45° field of view, 2352x1568px.
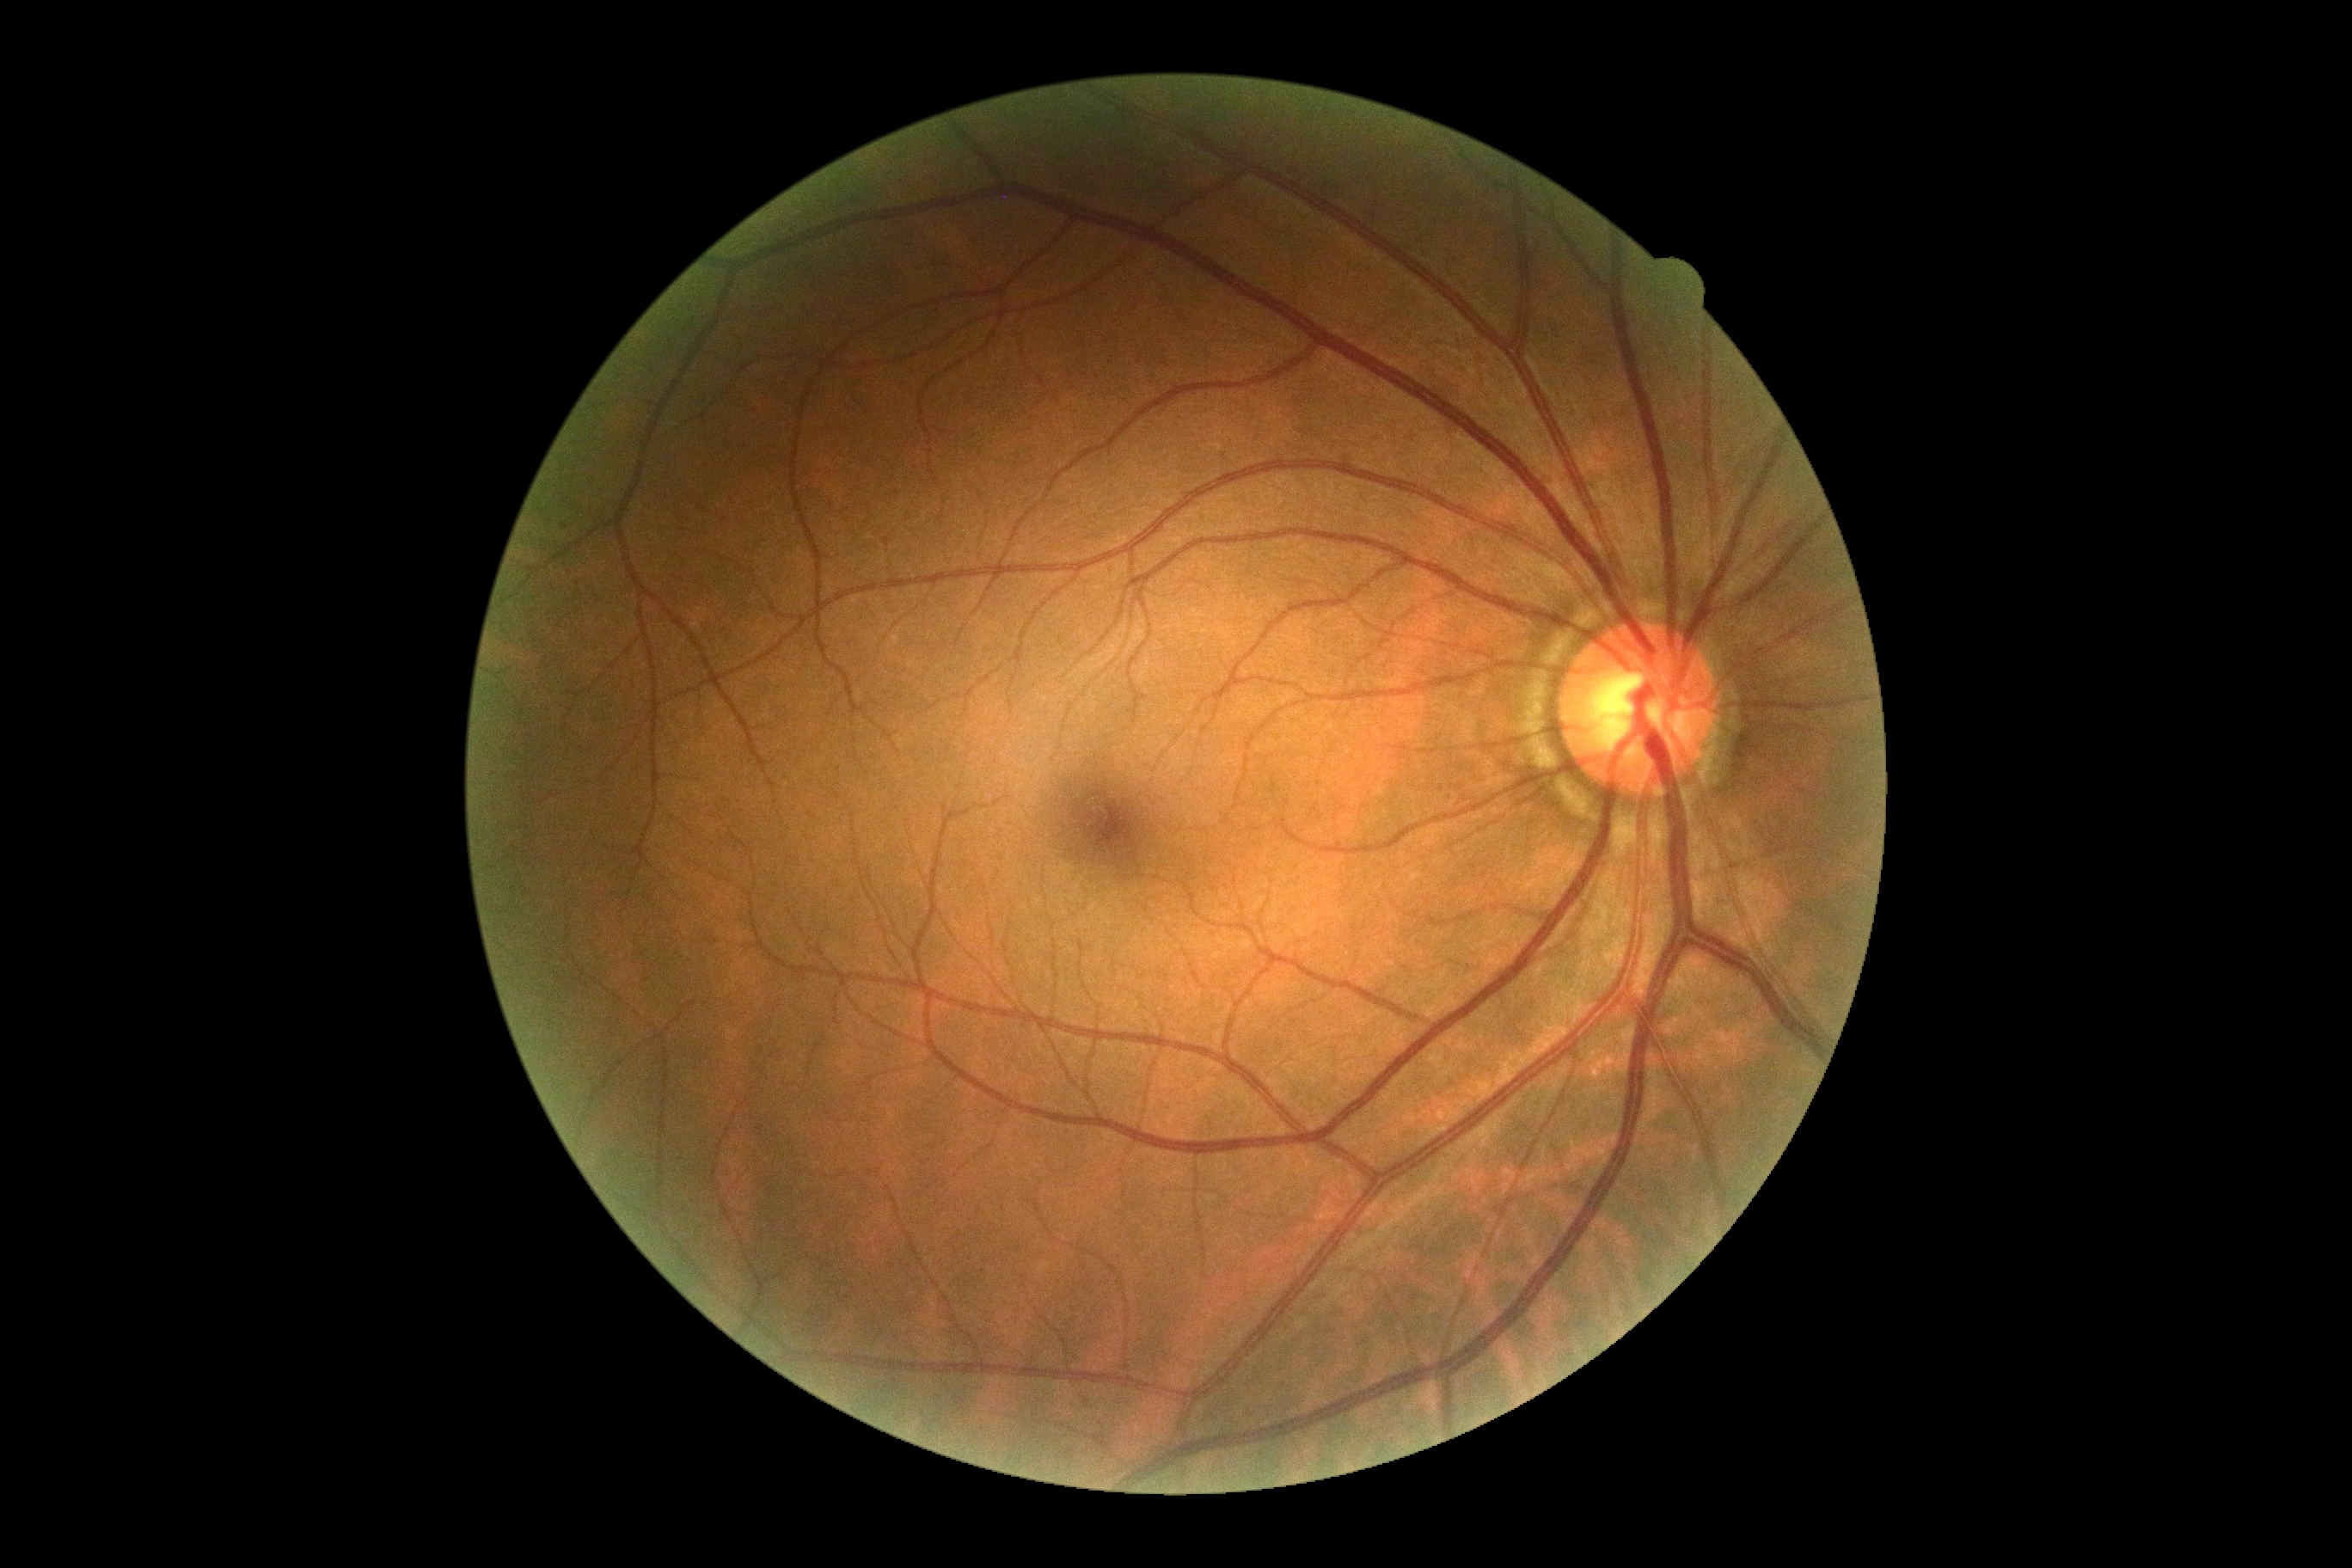 No apparent diabetic retinopathy. Diabetic retinopathy grade: 0/4.